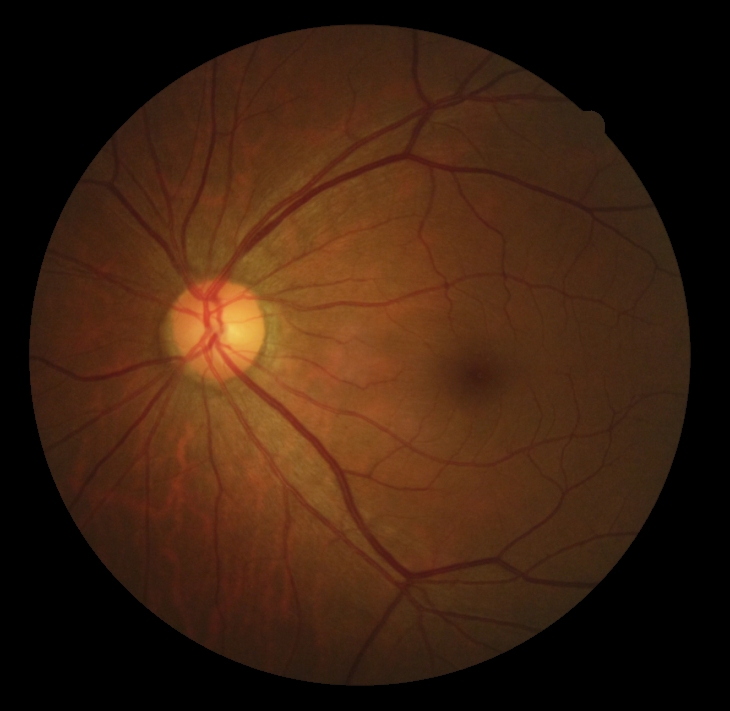

No signs of diabetic retinopathy.
Diabetic retinopathy grade is no apparent retinopathy (0).